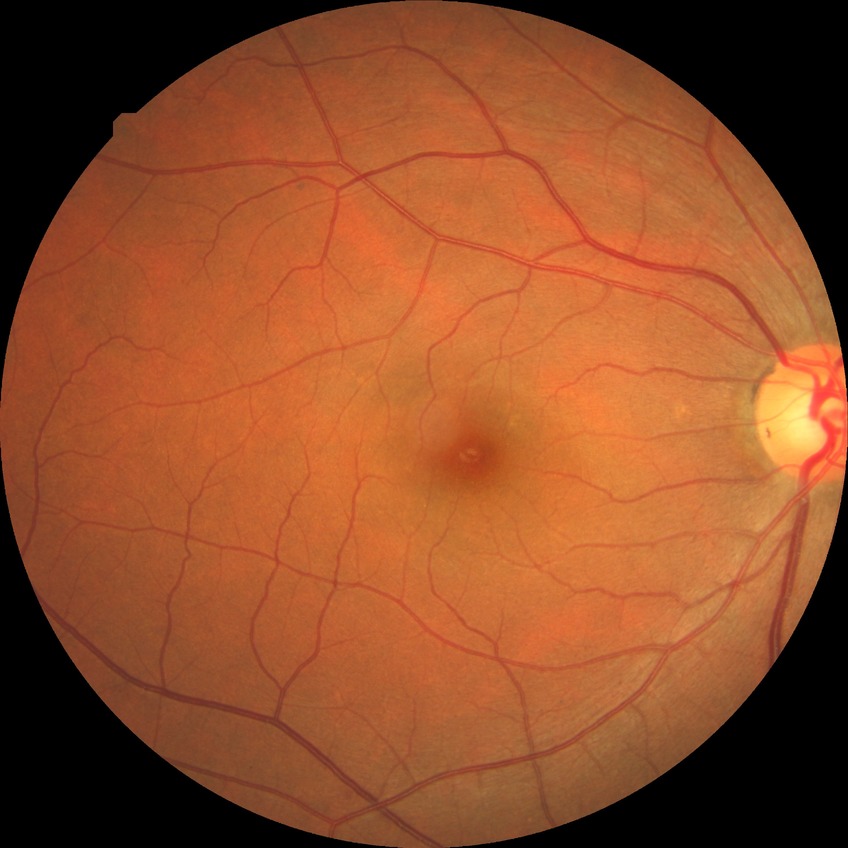 Davis grade is NDR.